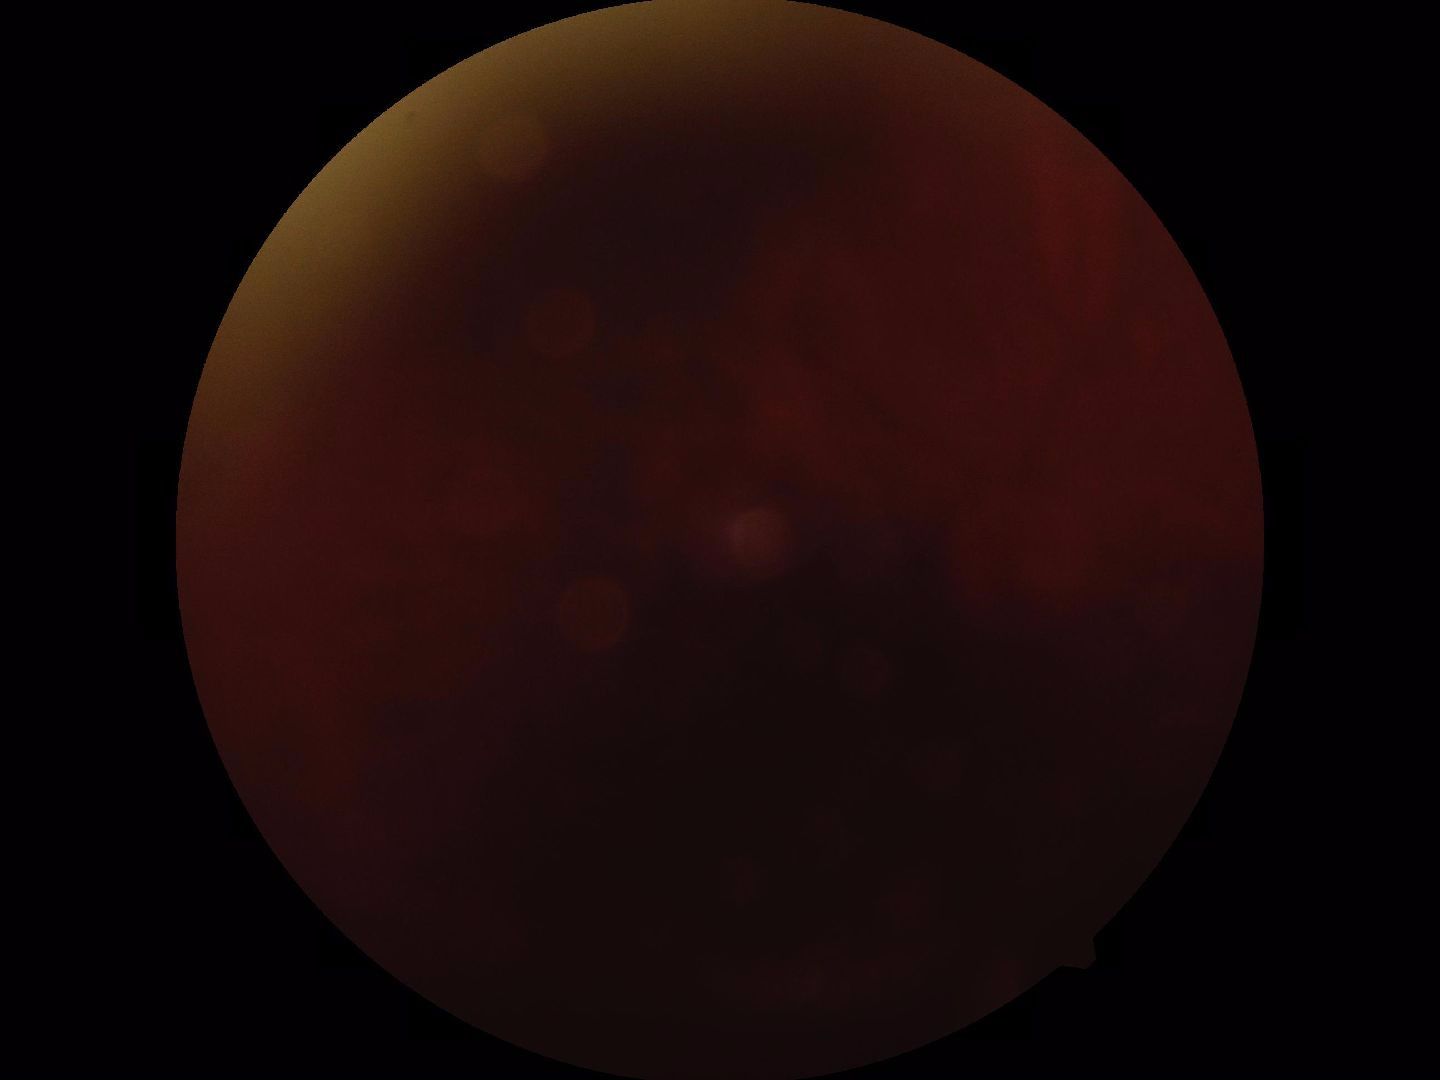

Quality: blurred, more than half the field obscured. Proliferative retinopathy: not identified.